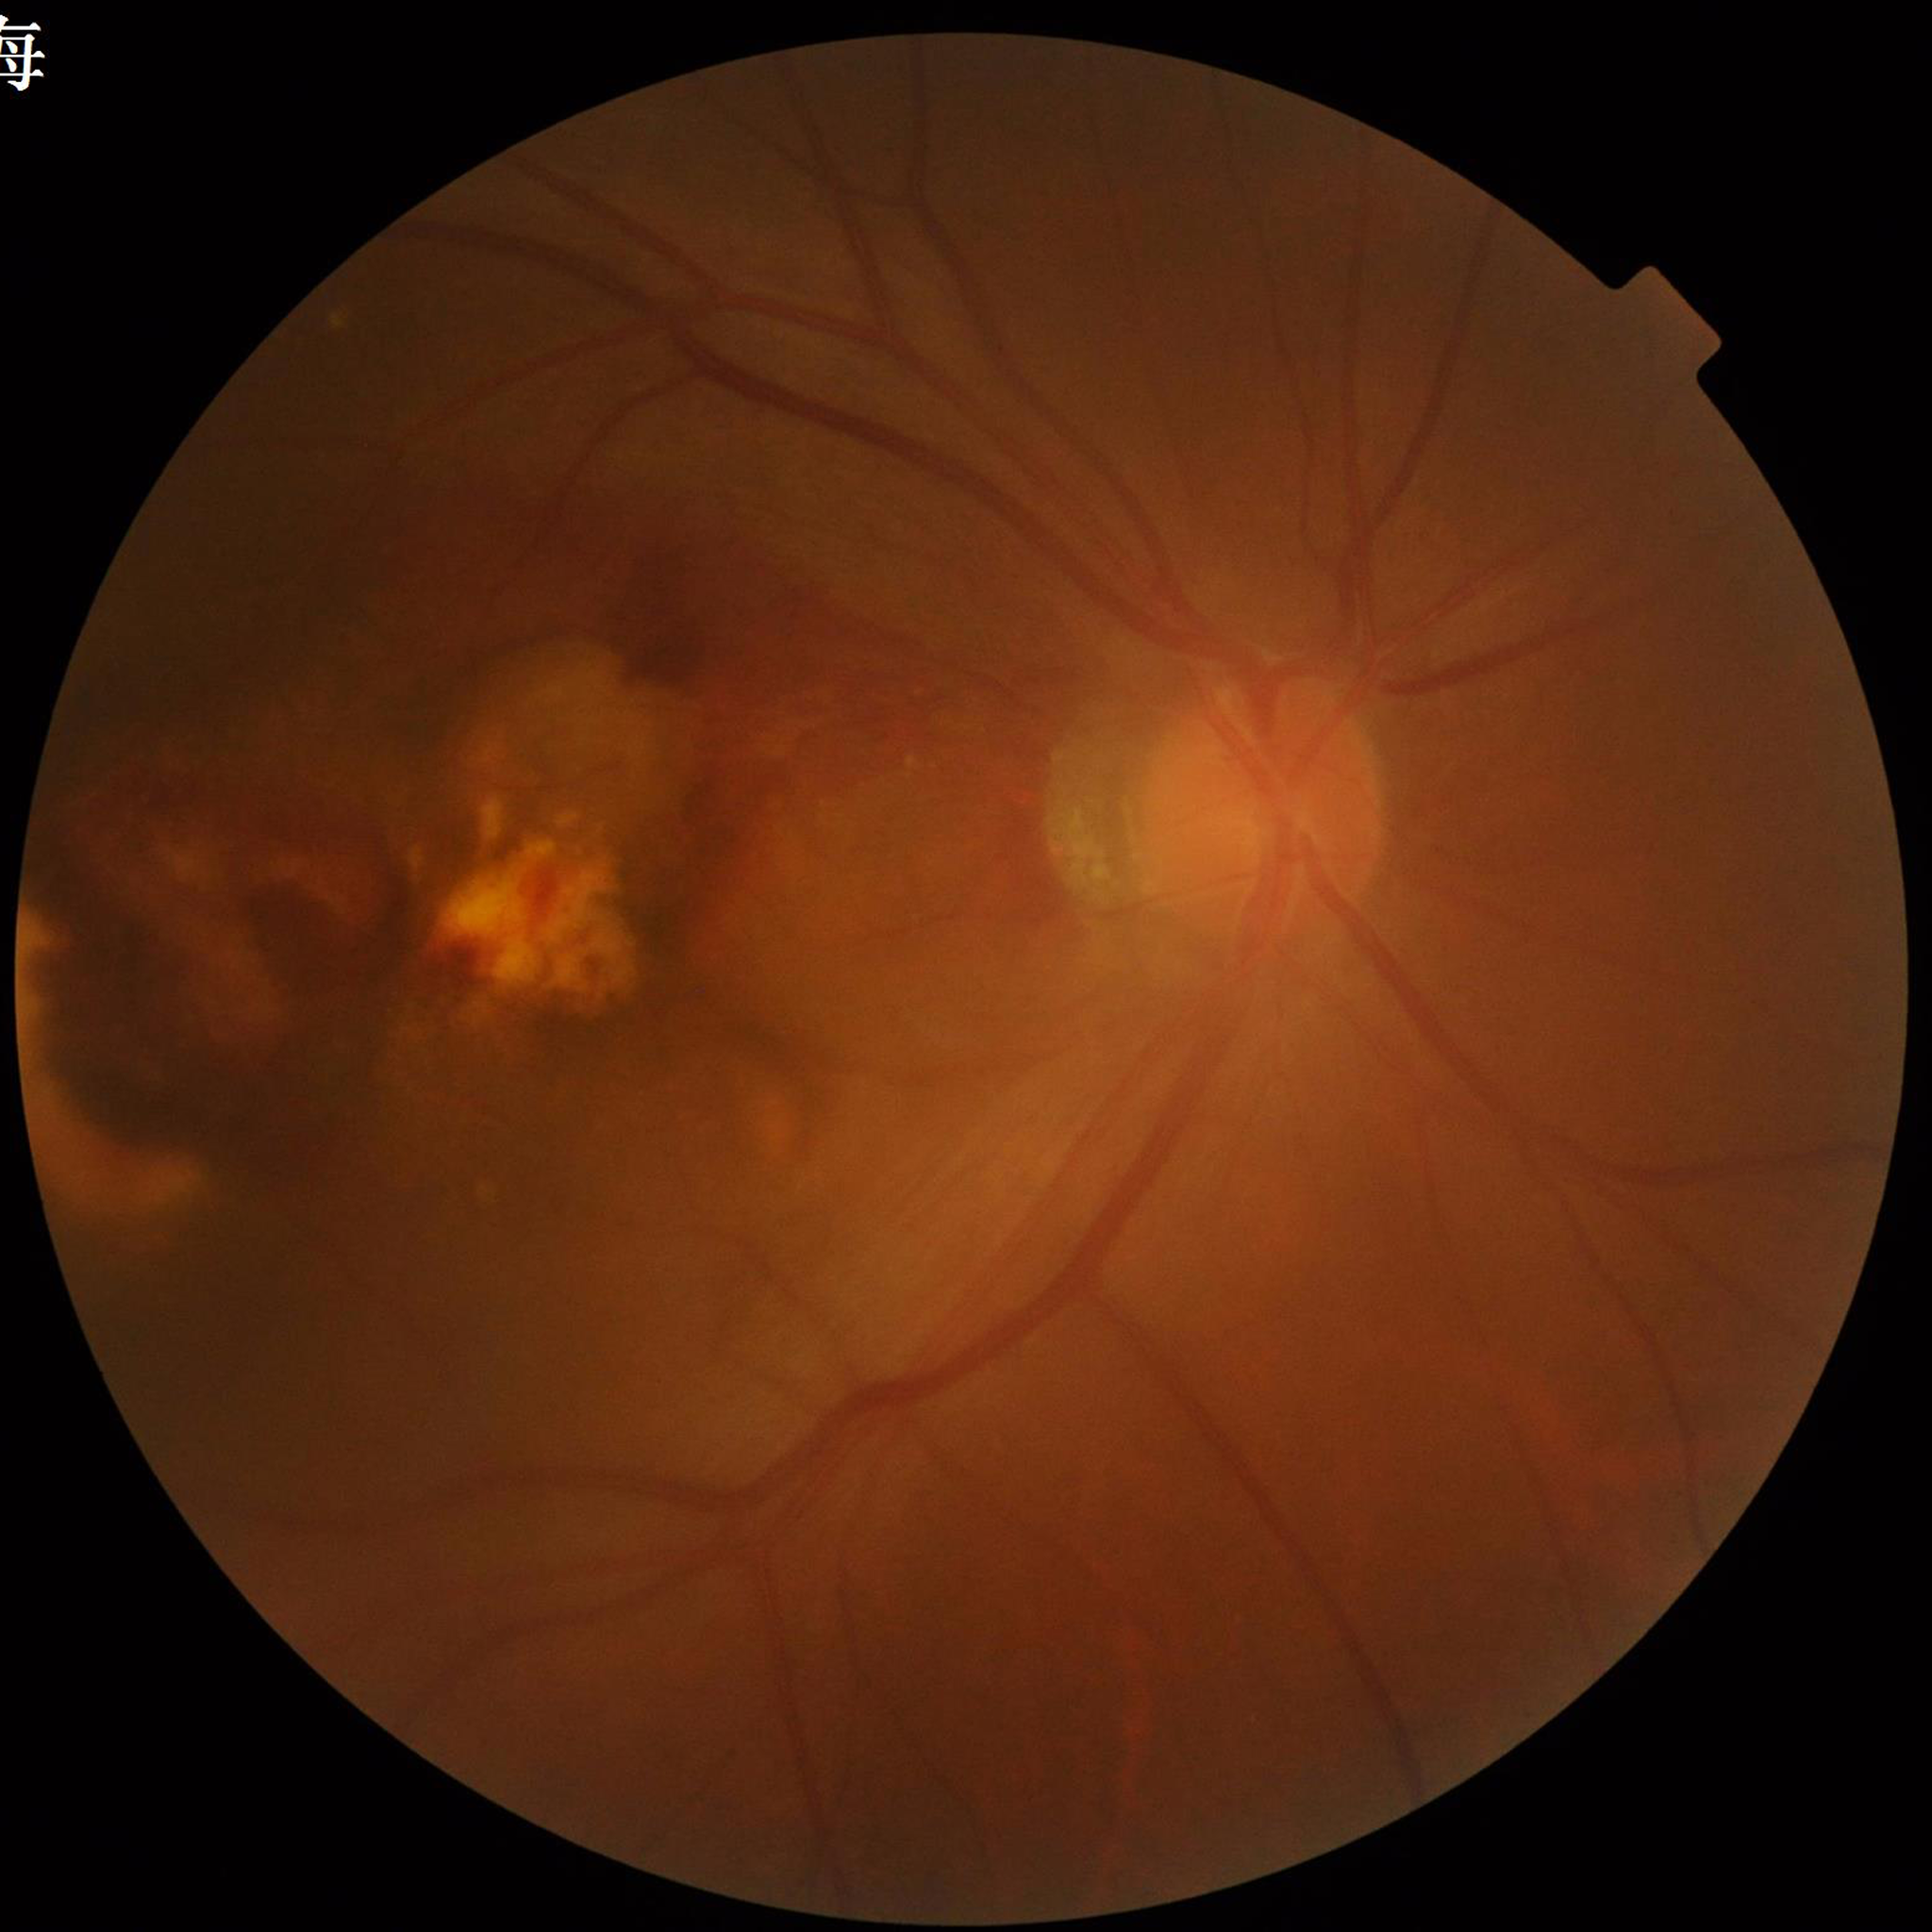

Impression = age-related macular degeneration | Photo quality = issues noted — blur.